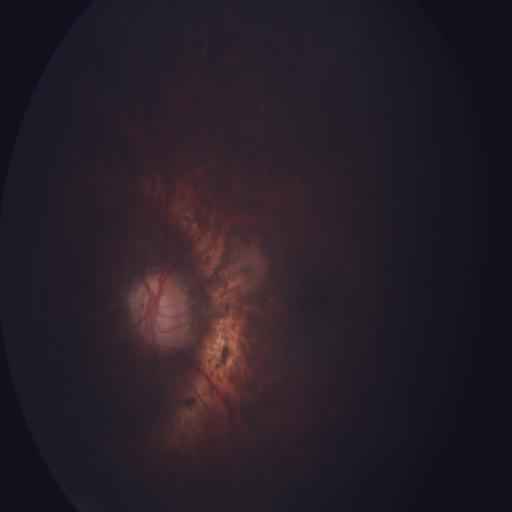 Findings (3): ODC (optic disc cupping) | MH (media haze) | MYA (myopia).